Davis DR grading.
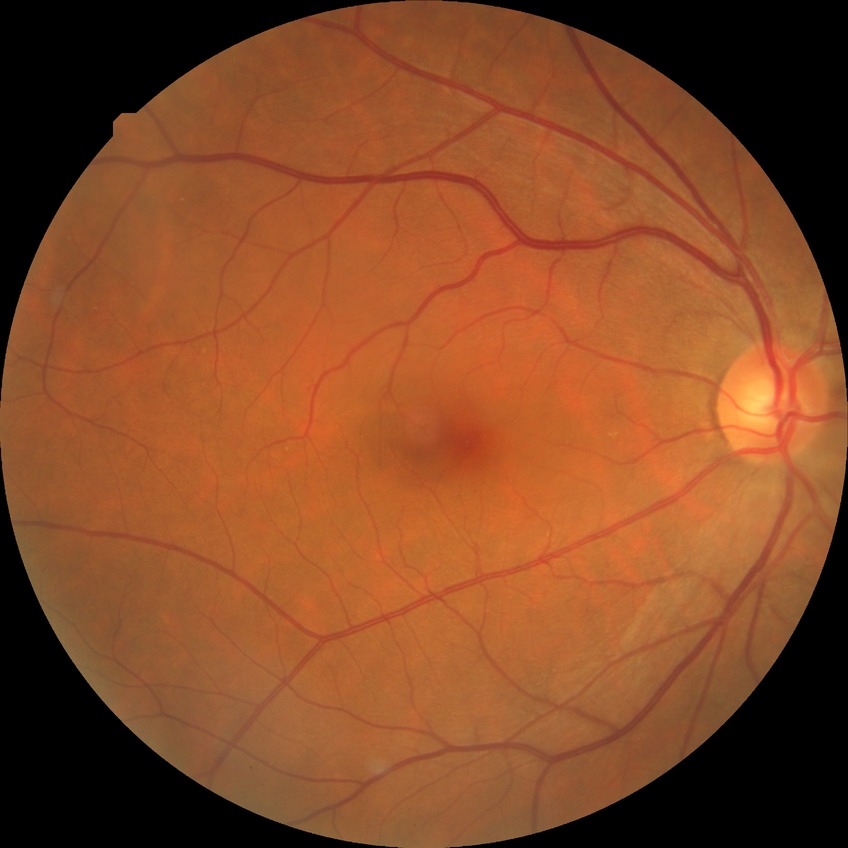
diabetic retinopathy (DR) = NDR (no diabetic retinopathy)